Infant wide-field fundus photograph.
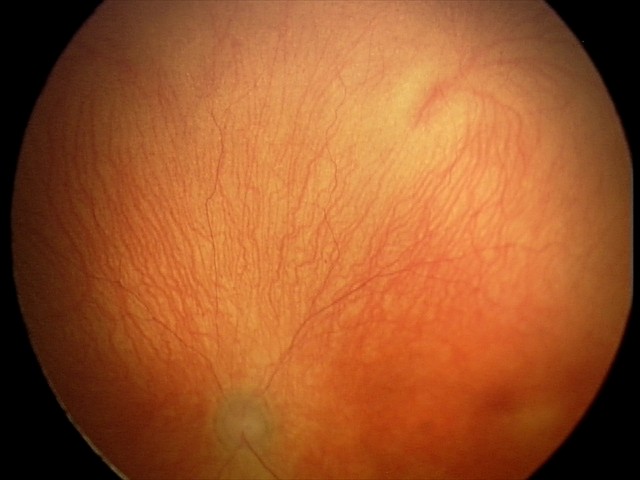 Series diagnosed as aggressive ROP (A-ROP) — rapidly progressive severe ROP with prominent plus disease, often without classic stage progression. Plus disease present.